45 degree fundus photograph: 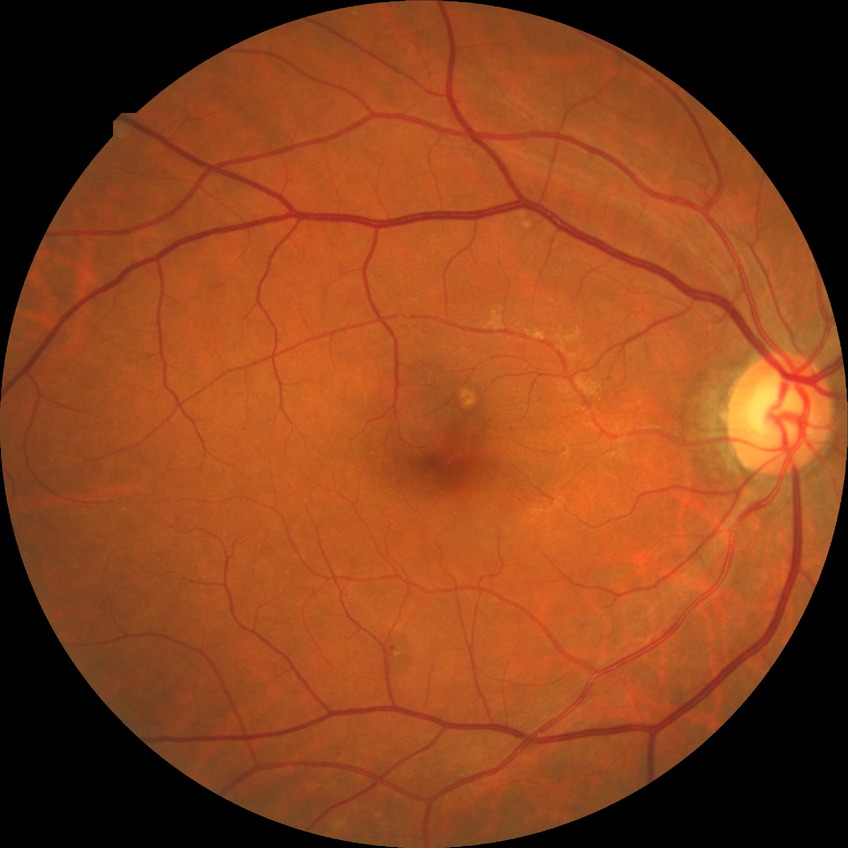 diabetic retinopathy (DR): SDR (simple diabetic retinopathy).